Wide-field contact fundus photograph of an infant — 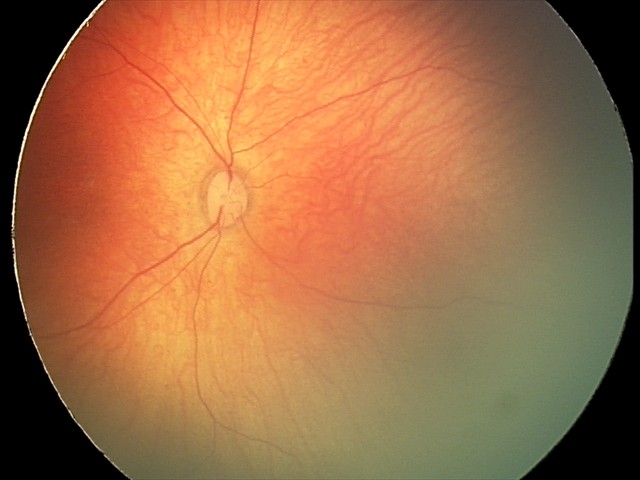
Assessment = physiological appearance.